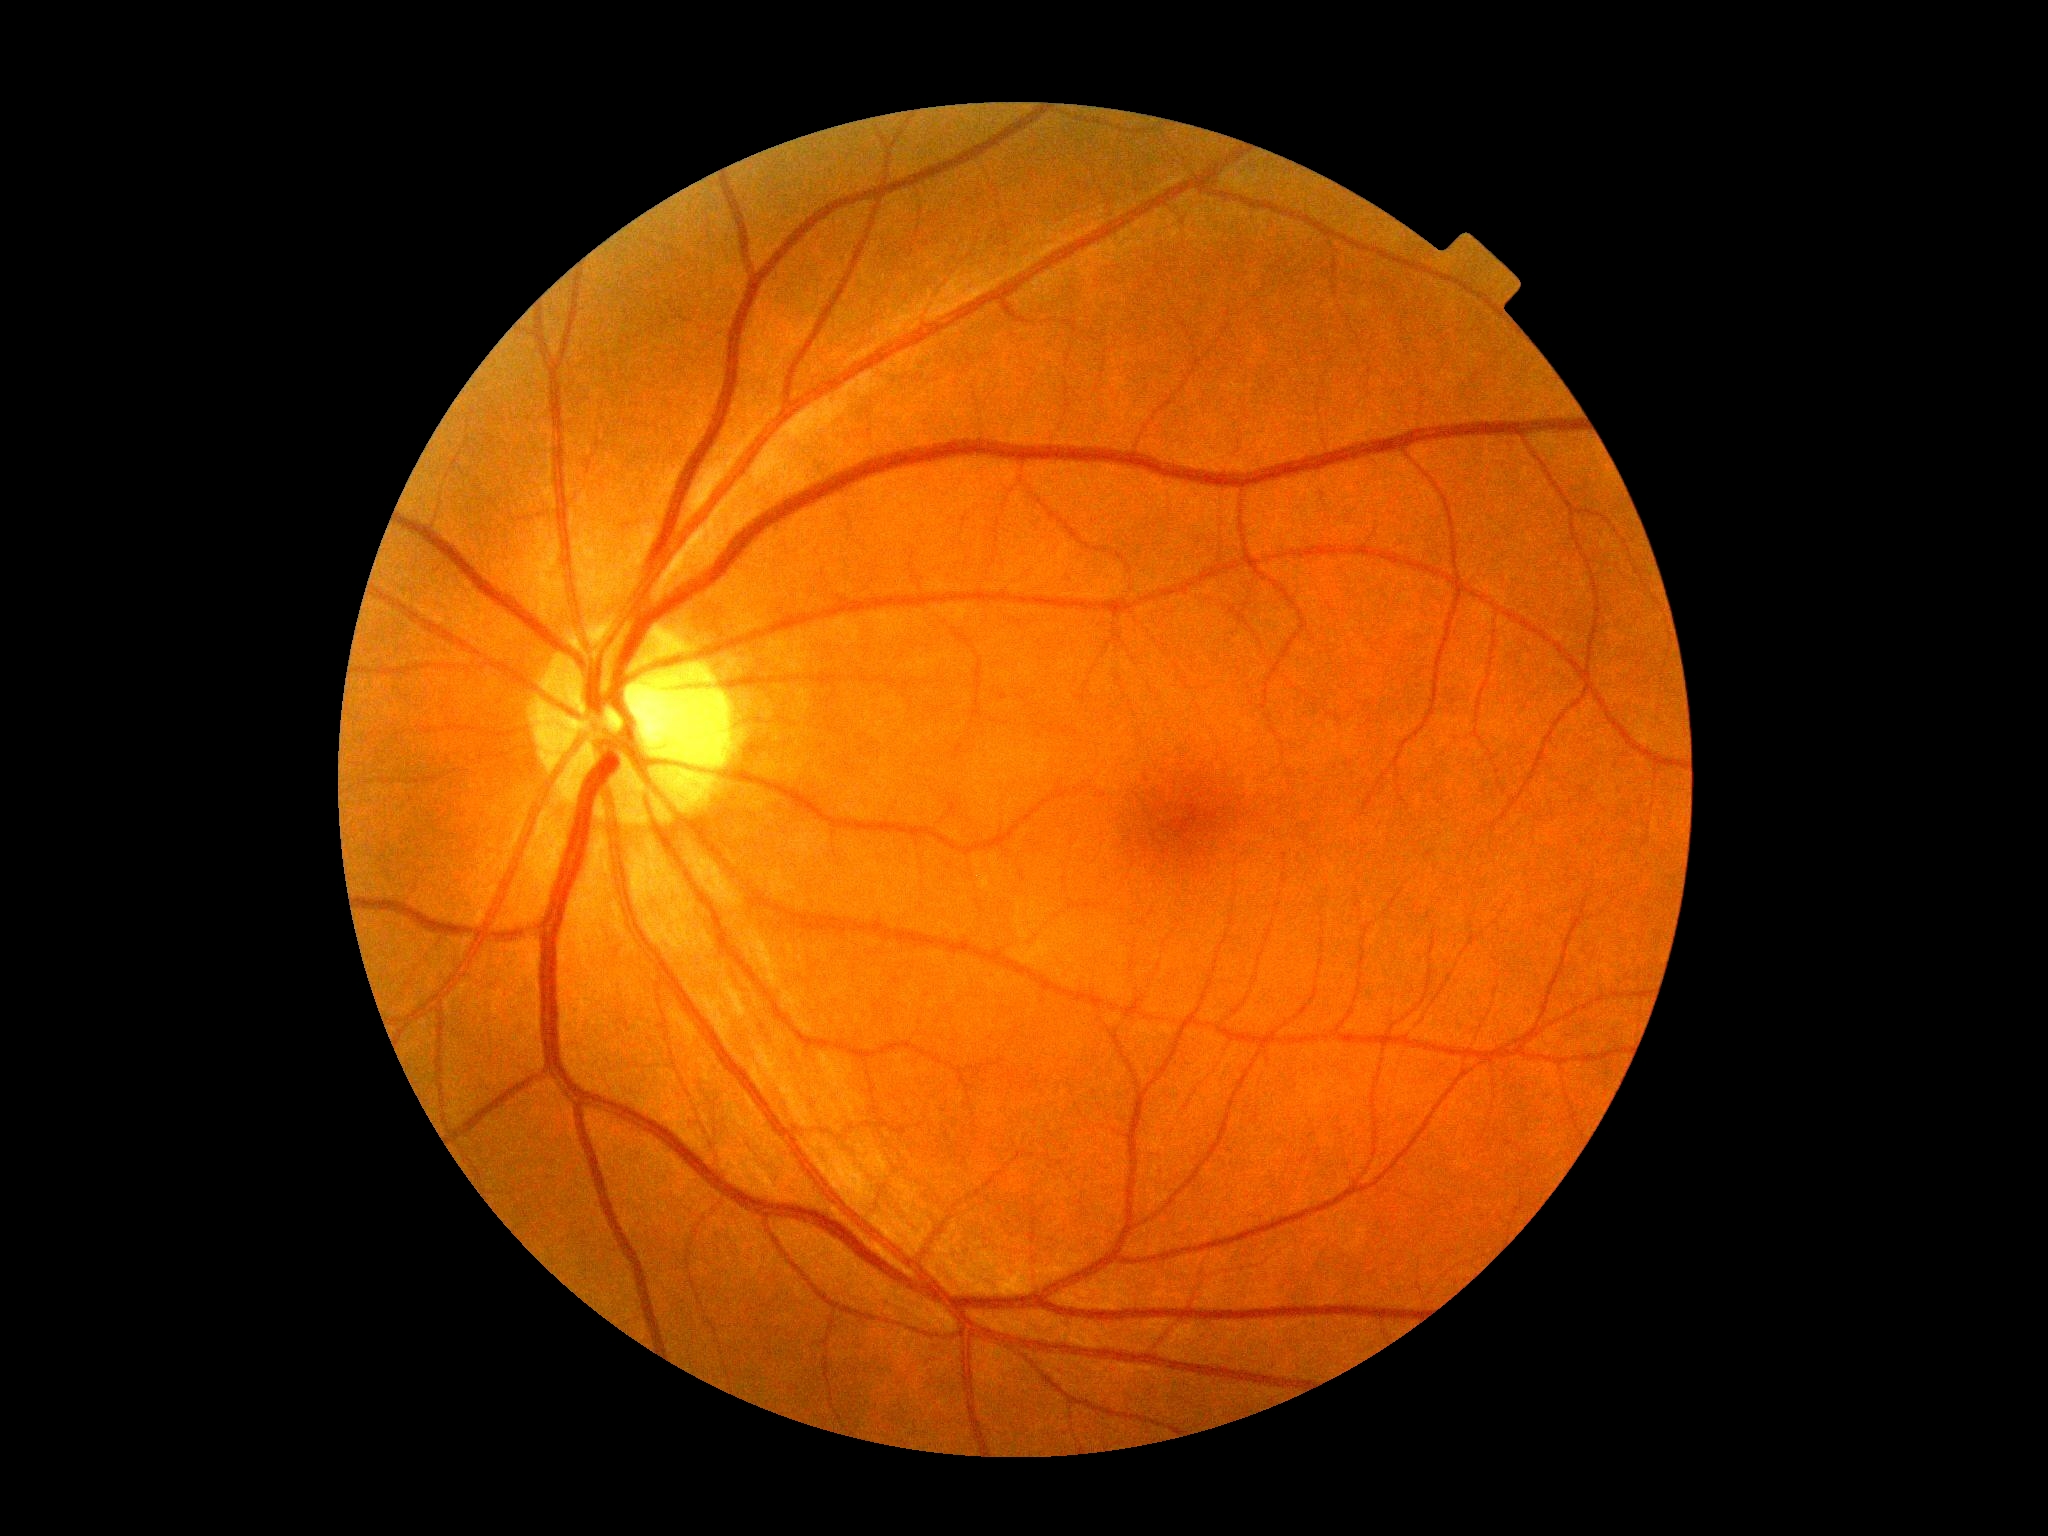

DR severity is 0/4.